Wide-field fundus photograph from neonatal ROP screening:
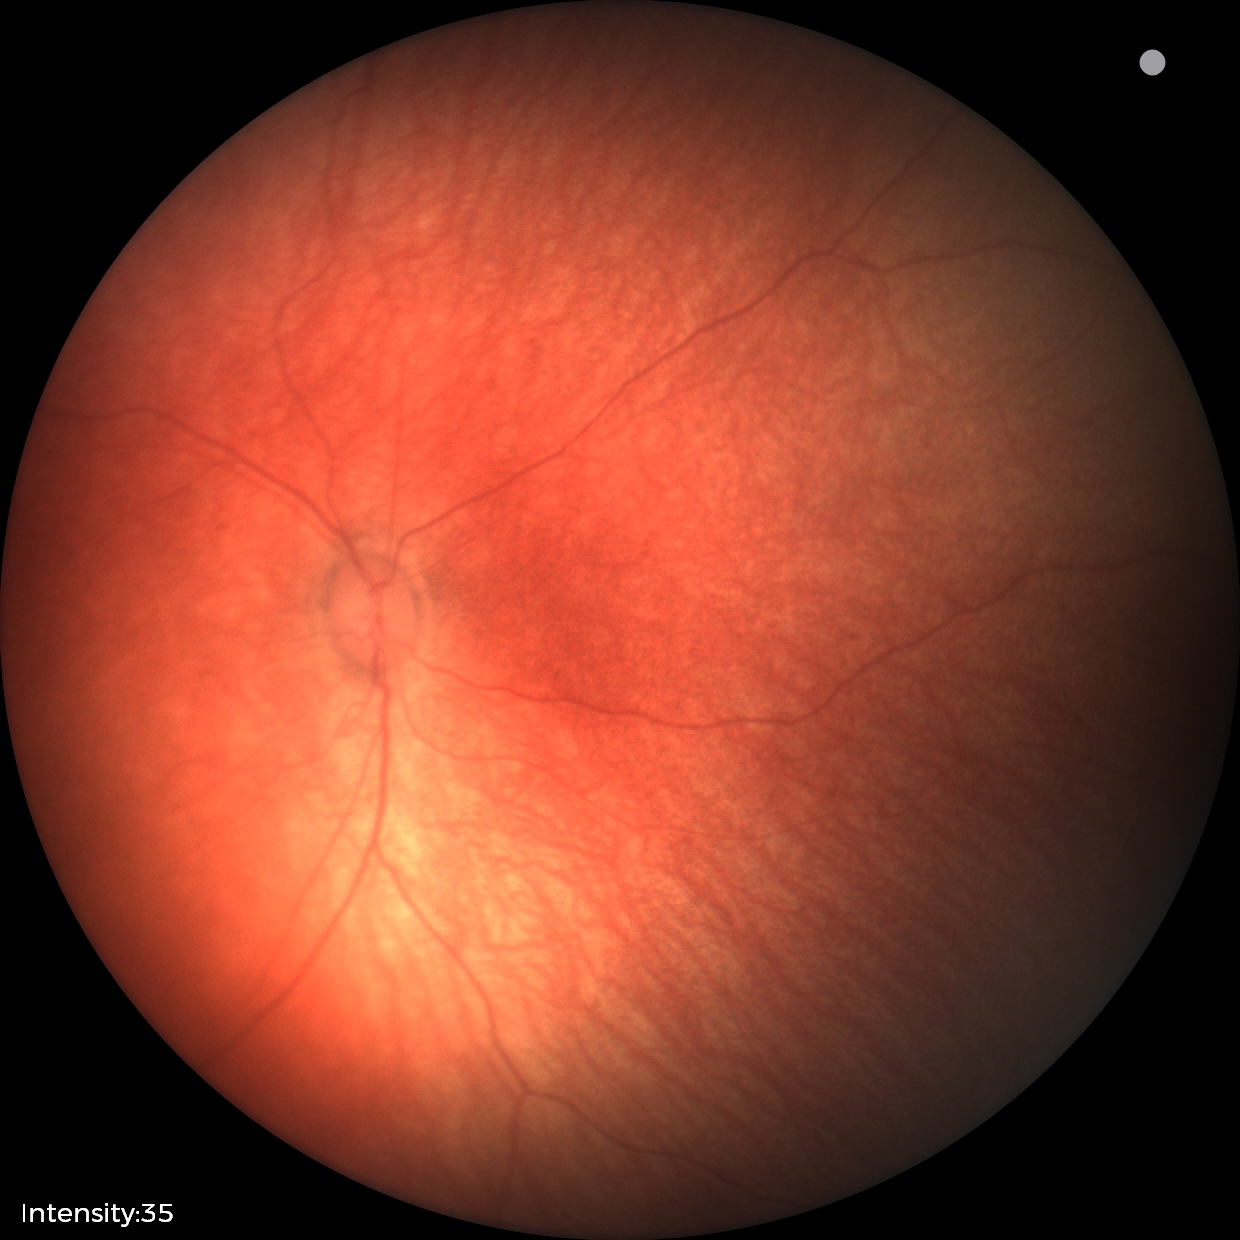

Impression = no abnormalities.